Color fundus image · 2048 x 1536 pixels · 45° field of view: 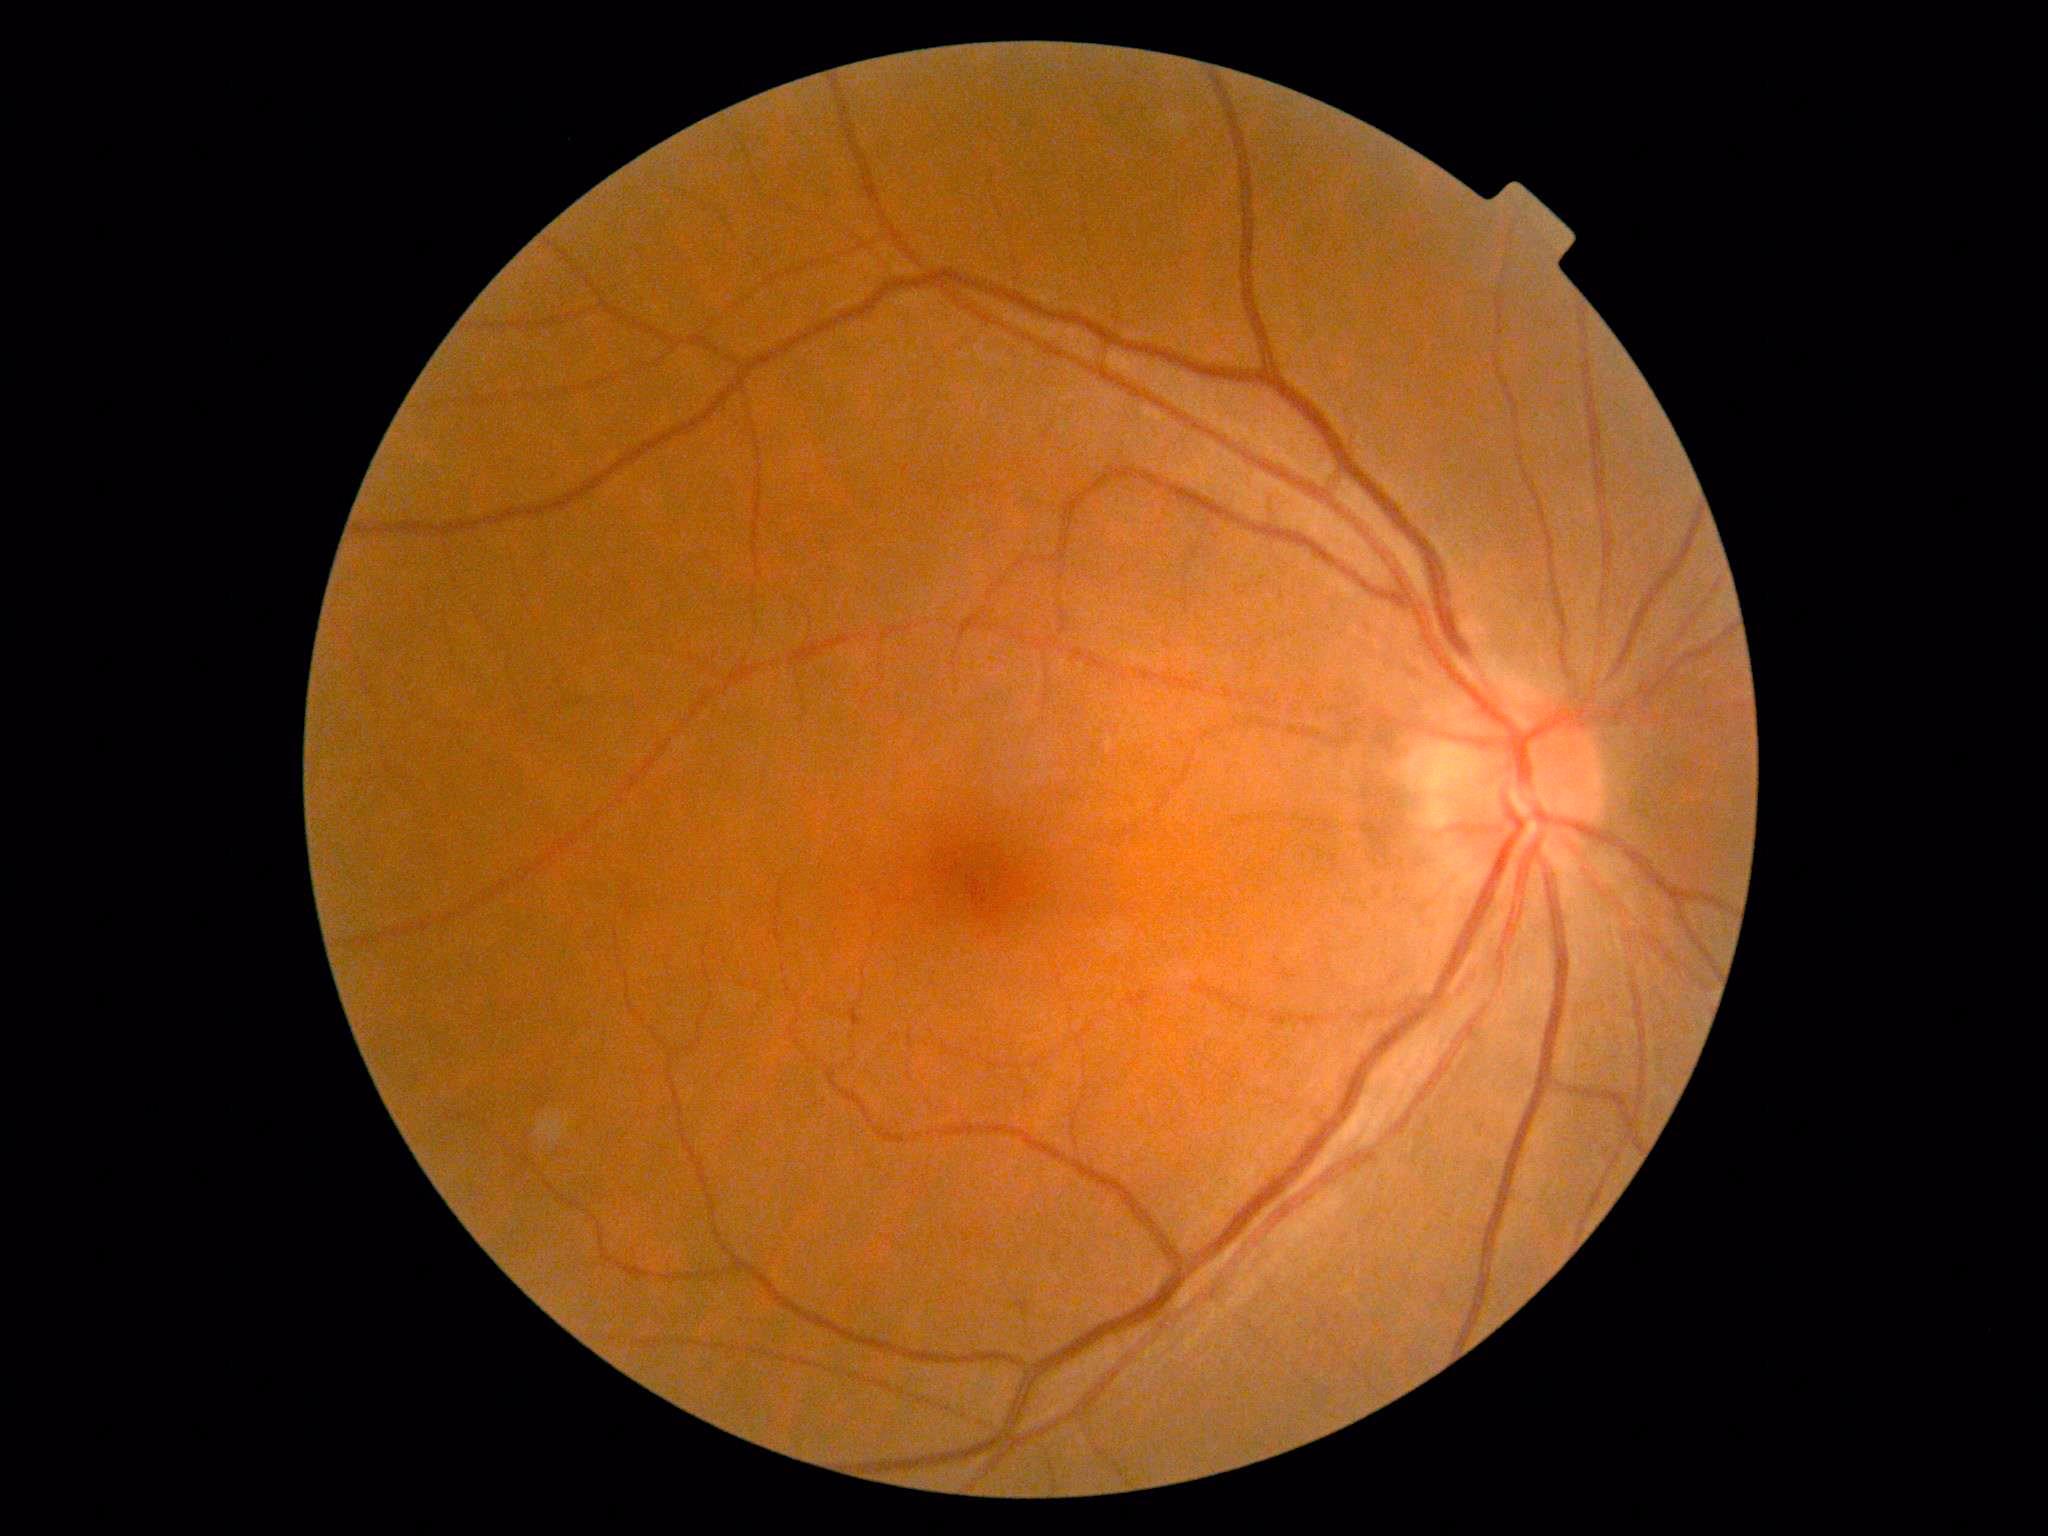

Diabetic retinopathy (DR): 0. No signs of diabetic retinopathy.